848 x 848 pixels · color fundus photograph · NIDEK AFC-230: 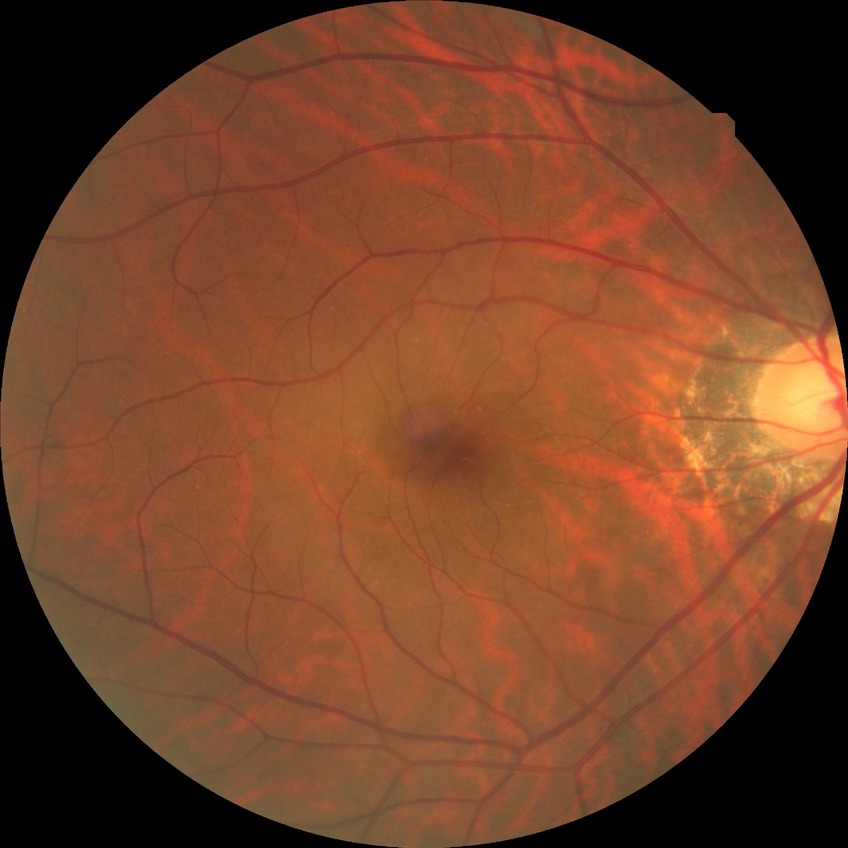
diabetic retinopathy (DR)=NDR (no diabetic retinopathy).